Image size 2352x1568
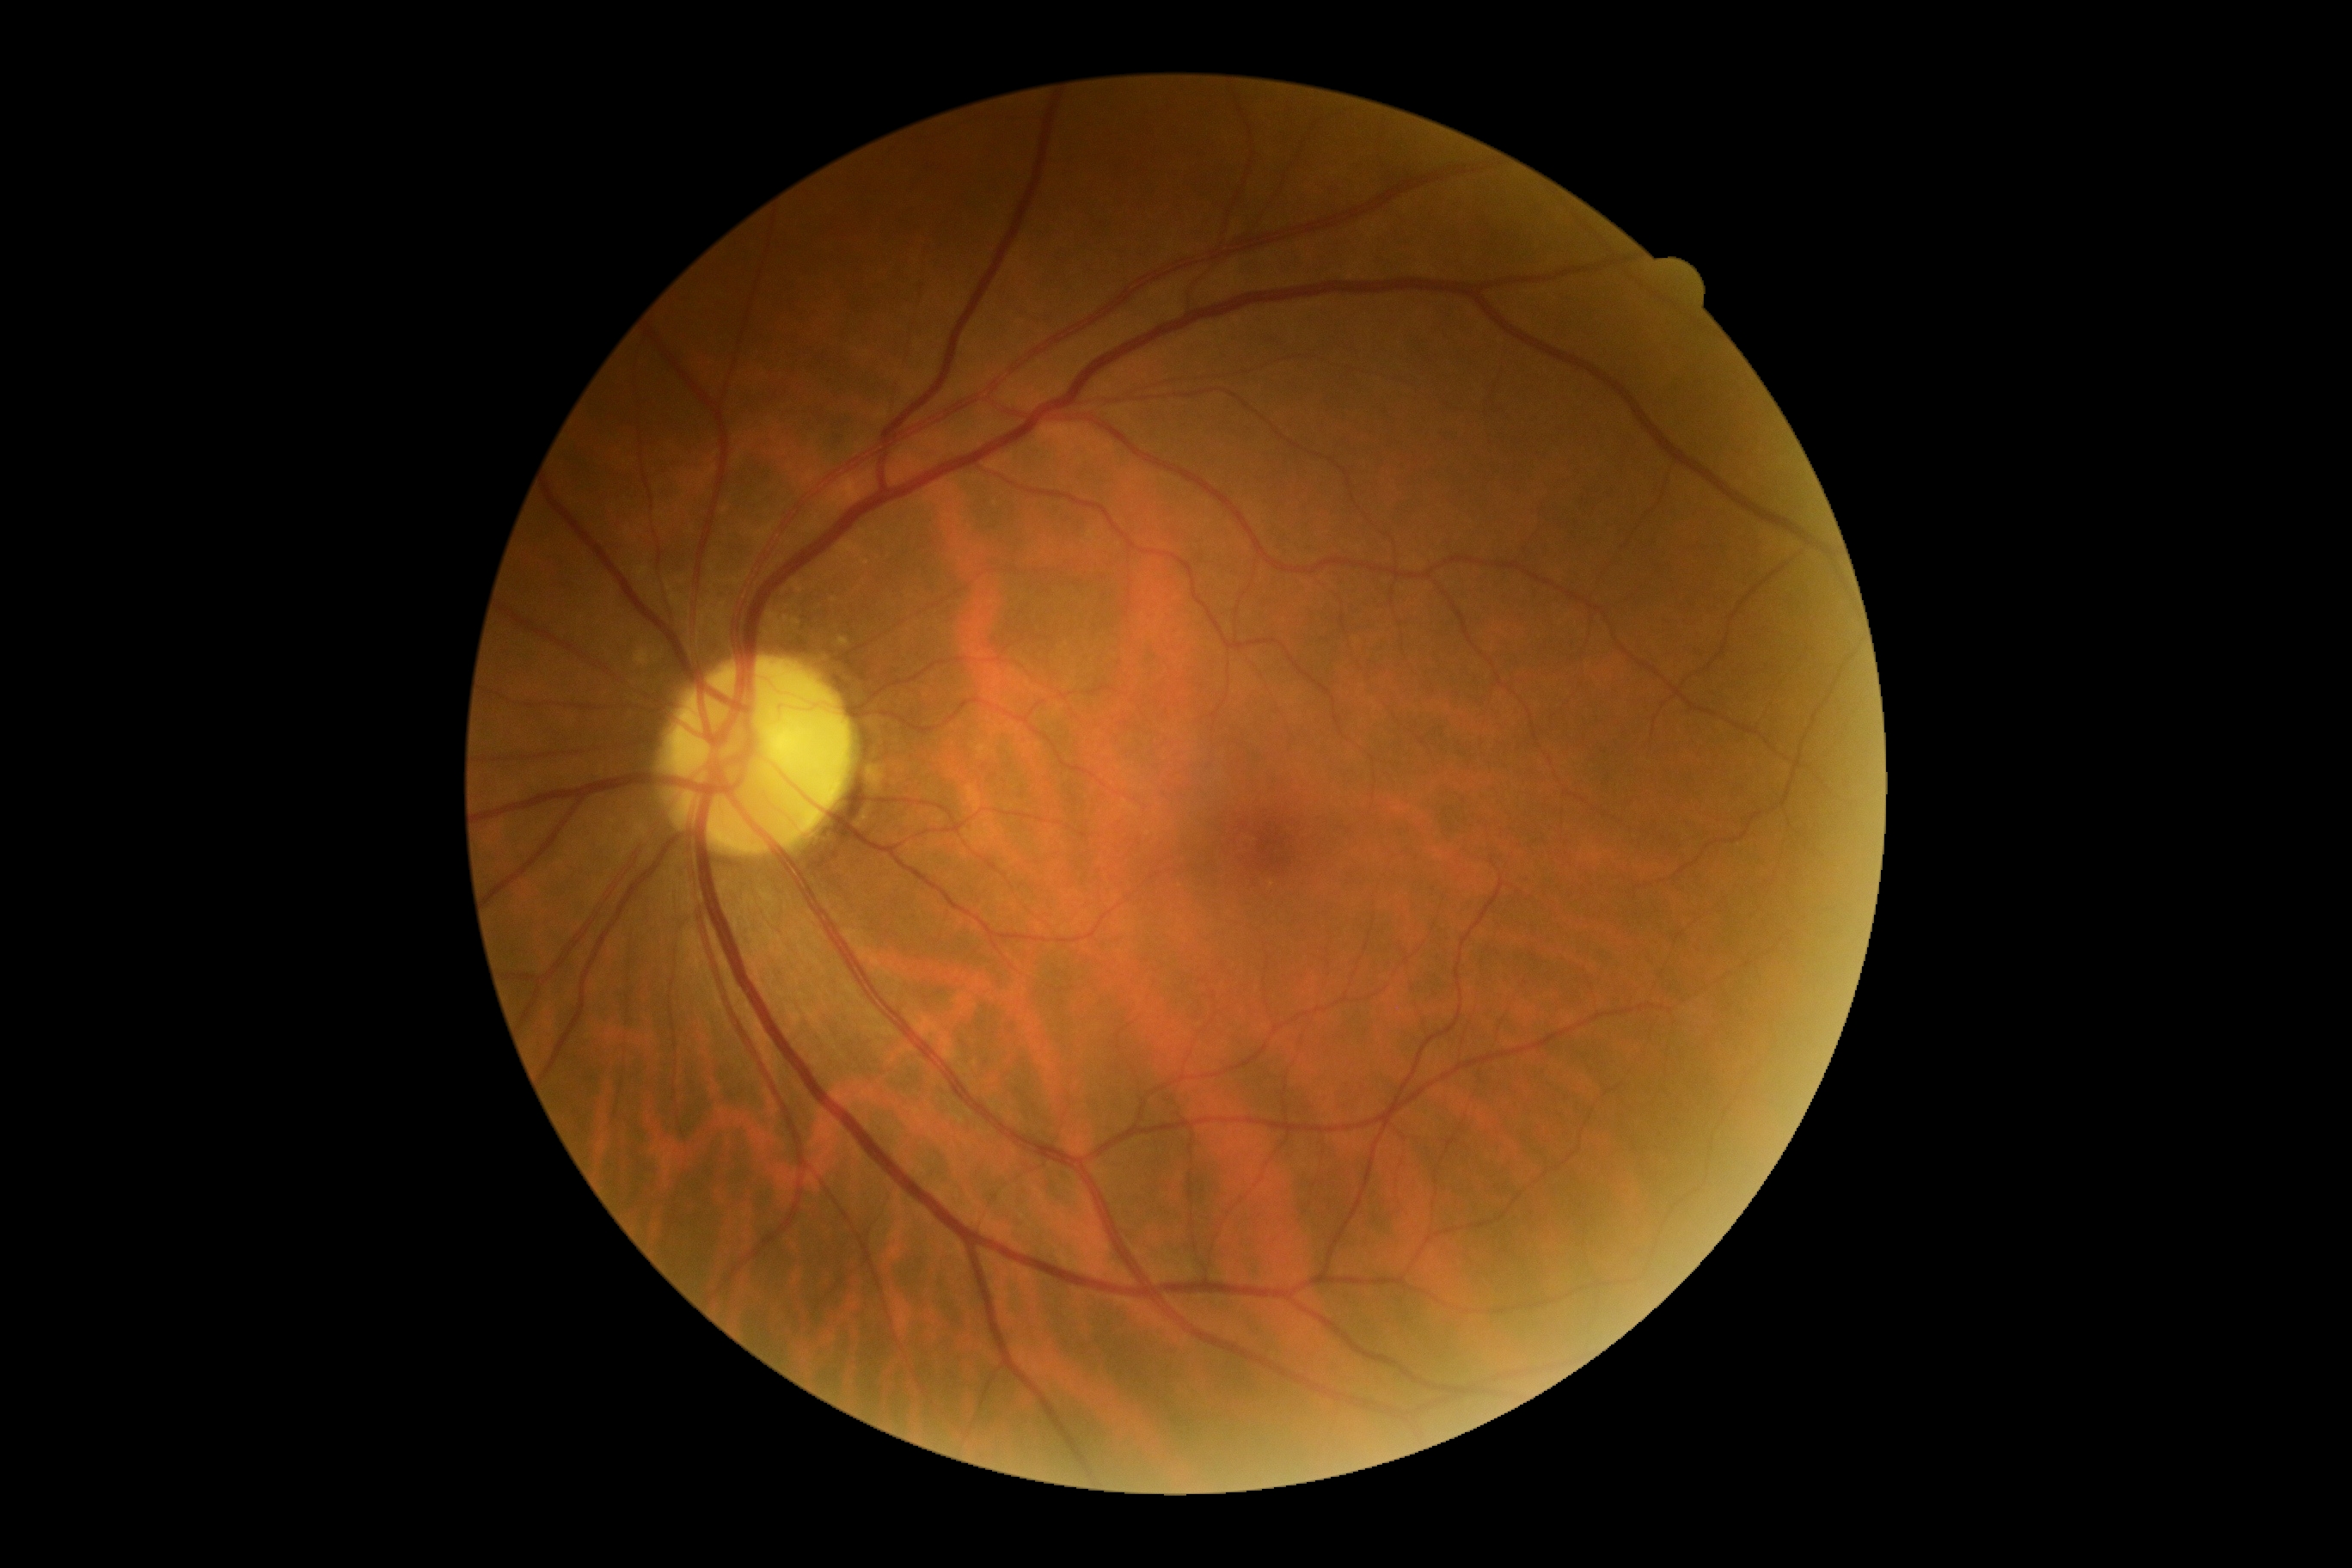

No apparent diabetic retinopathy. DR severity is 0.